Acquired on the Clarity RetCam 3 · wide-field fundus photograph of an infant · image size 640x480 — 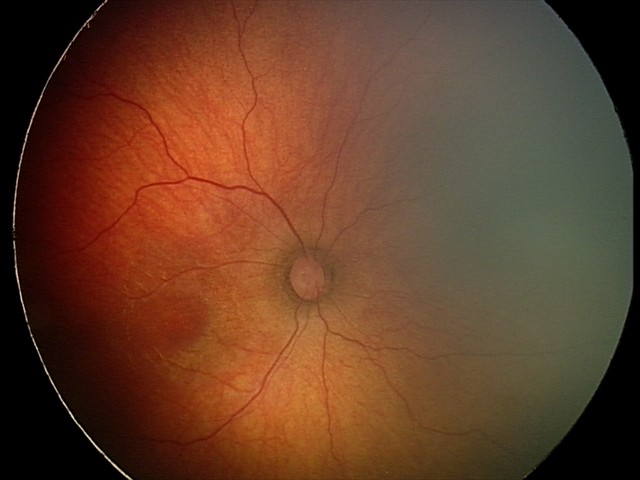 Screening diagnosis: status post retinopathy of prematurity — retinal appearance after treated retinopathy of prematurity | no plus disease.